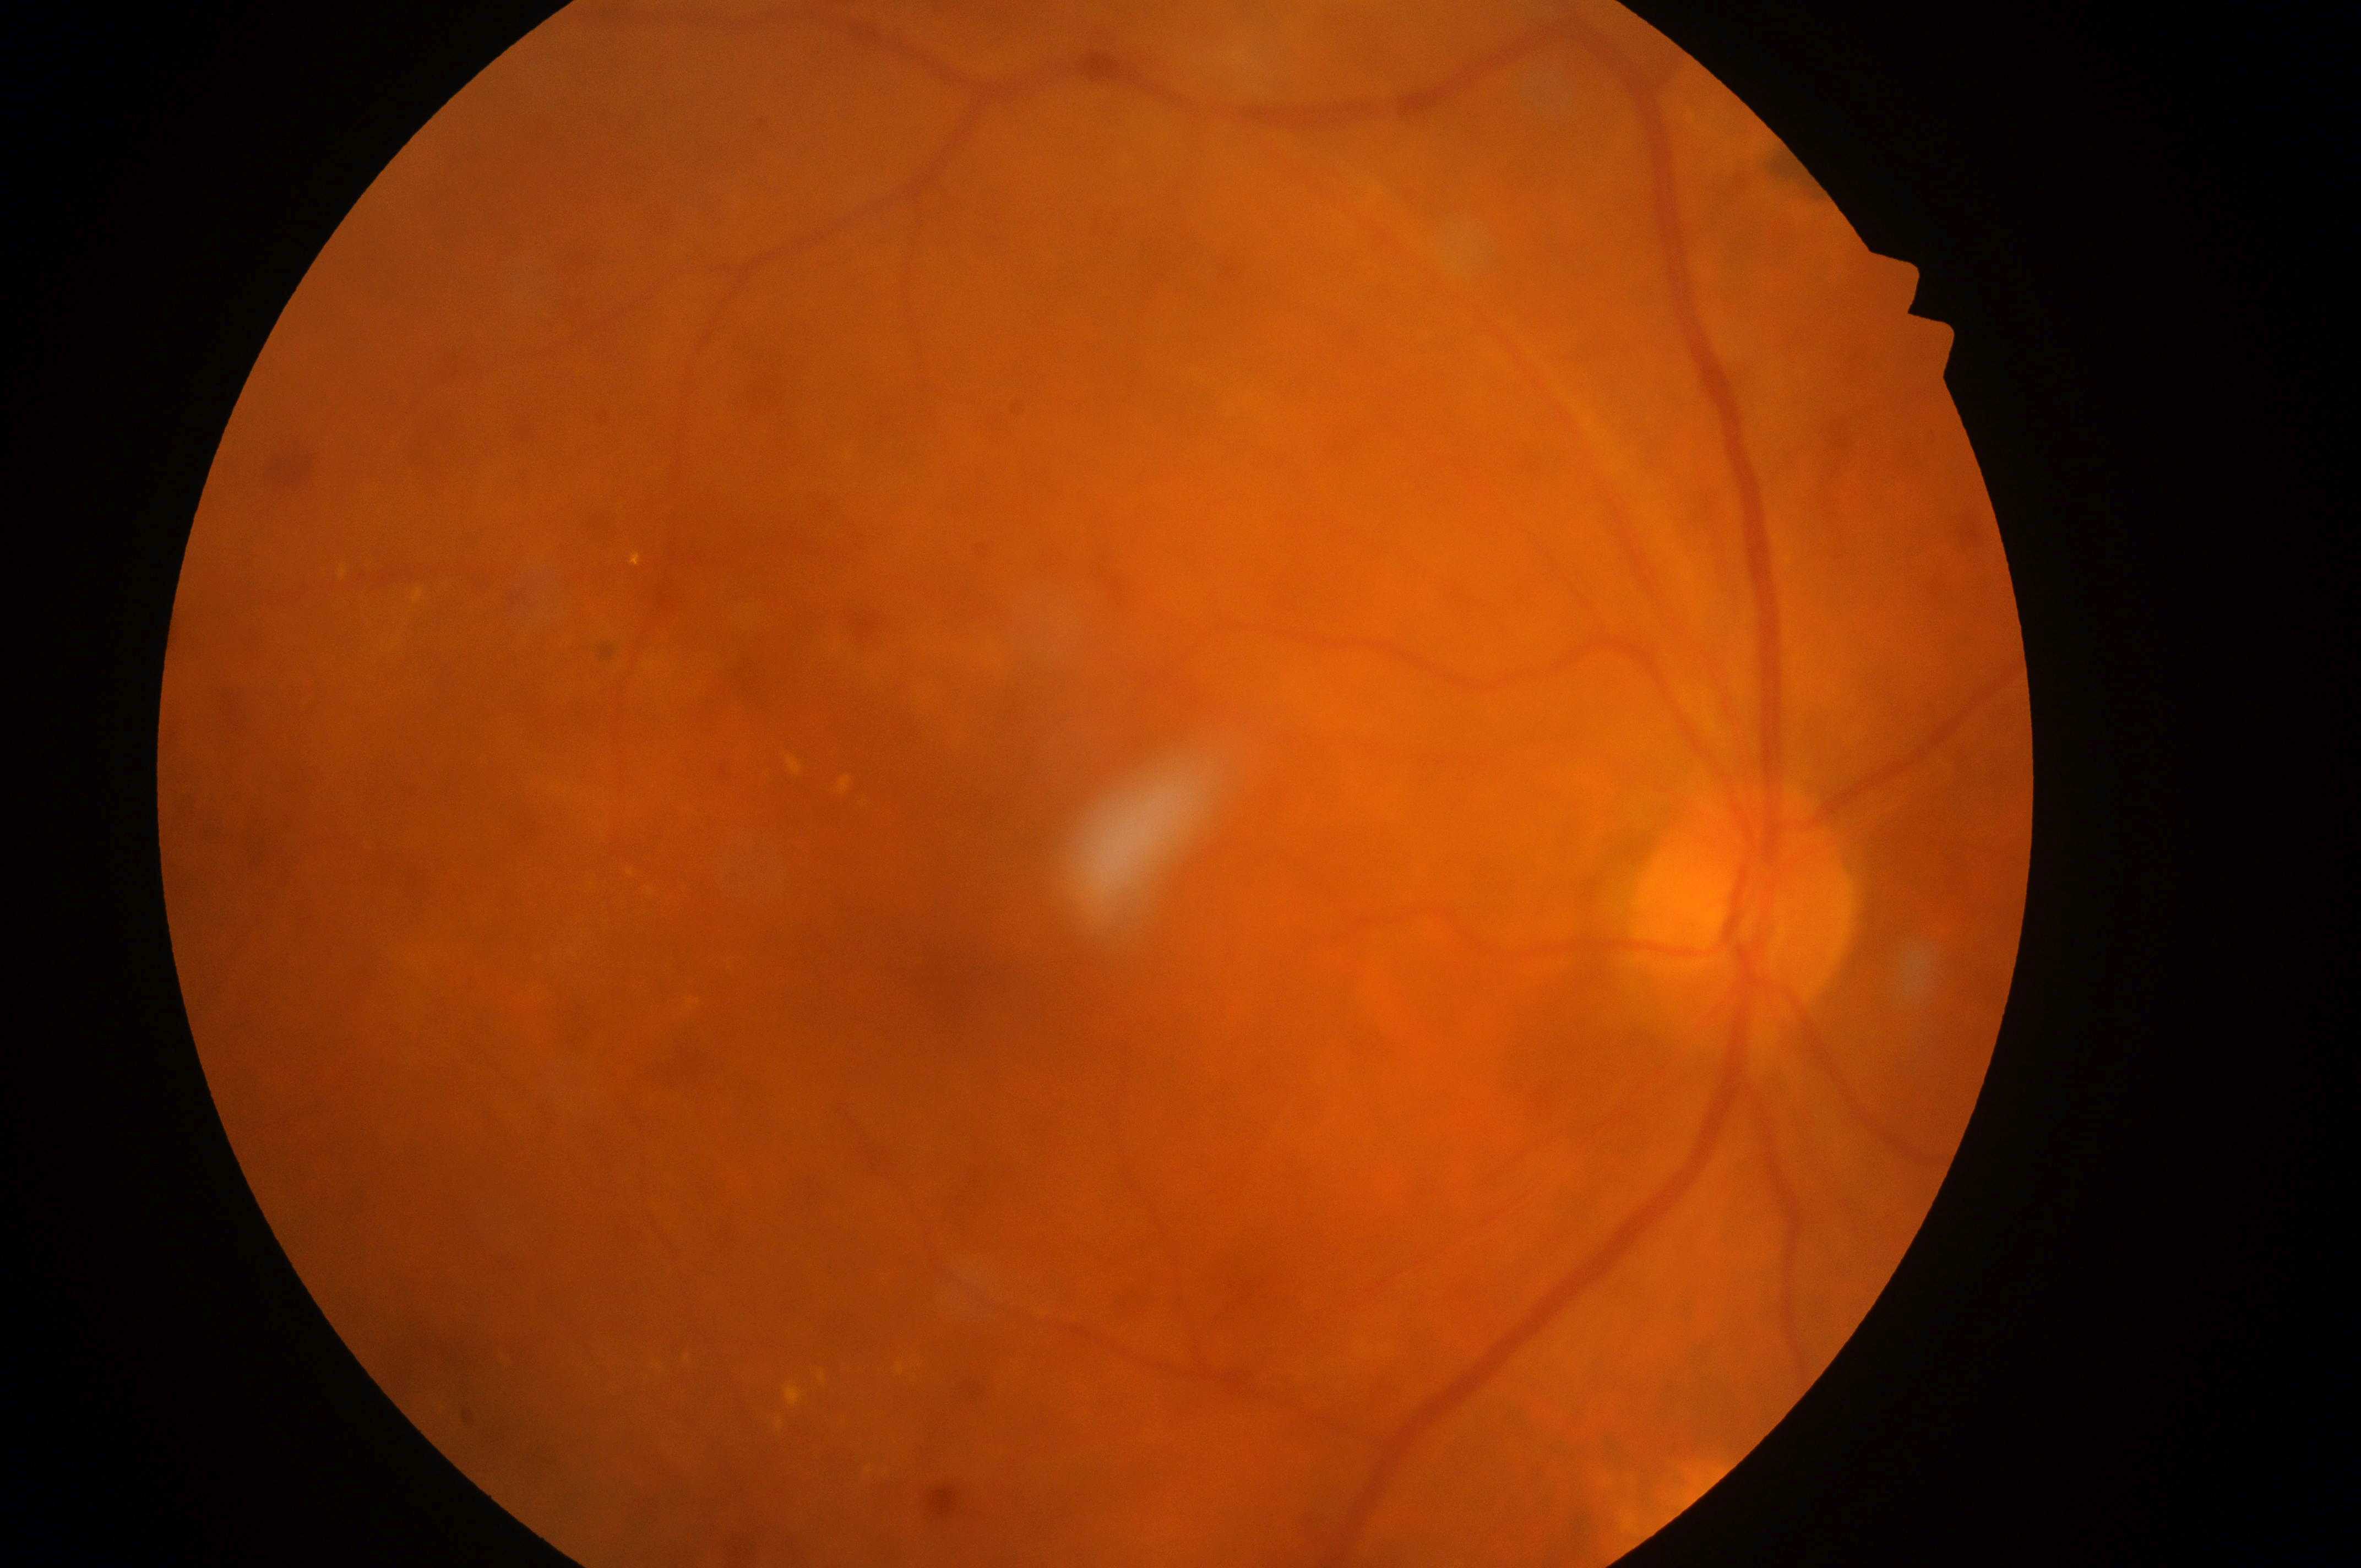

Disease class: non-proliferative diabetic retinopathy.
This is the OD.
Risk of diabetic macular edema is 2/2.
Optic nerve head: (x=1743, y=923).
The fovea centralis is at (x=967, y=986).
Diabetic retinopathy is 2/4.